Fundus photo. 45-degree field of view. 2048x1536px — 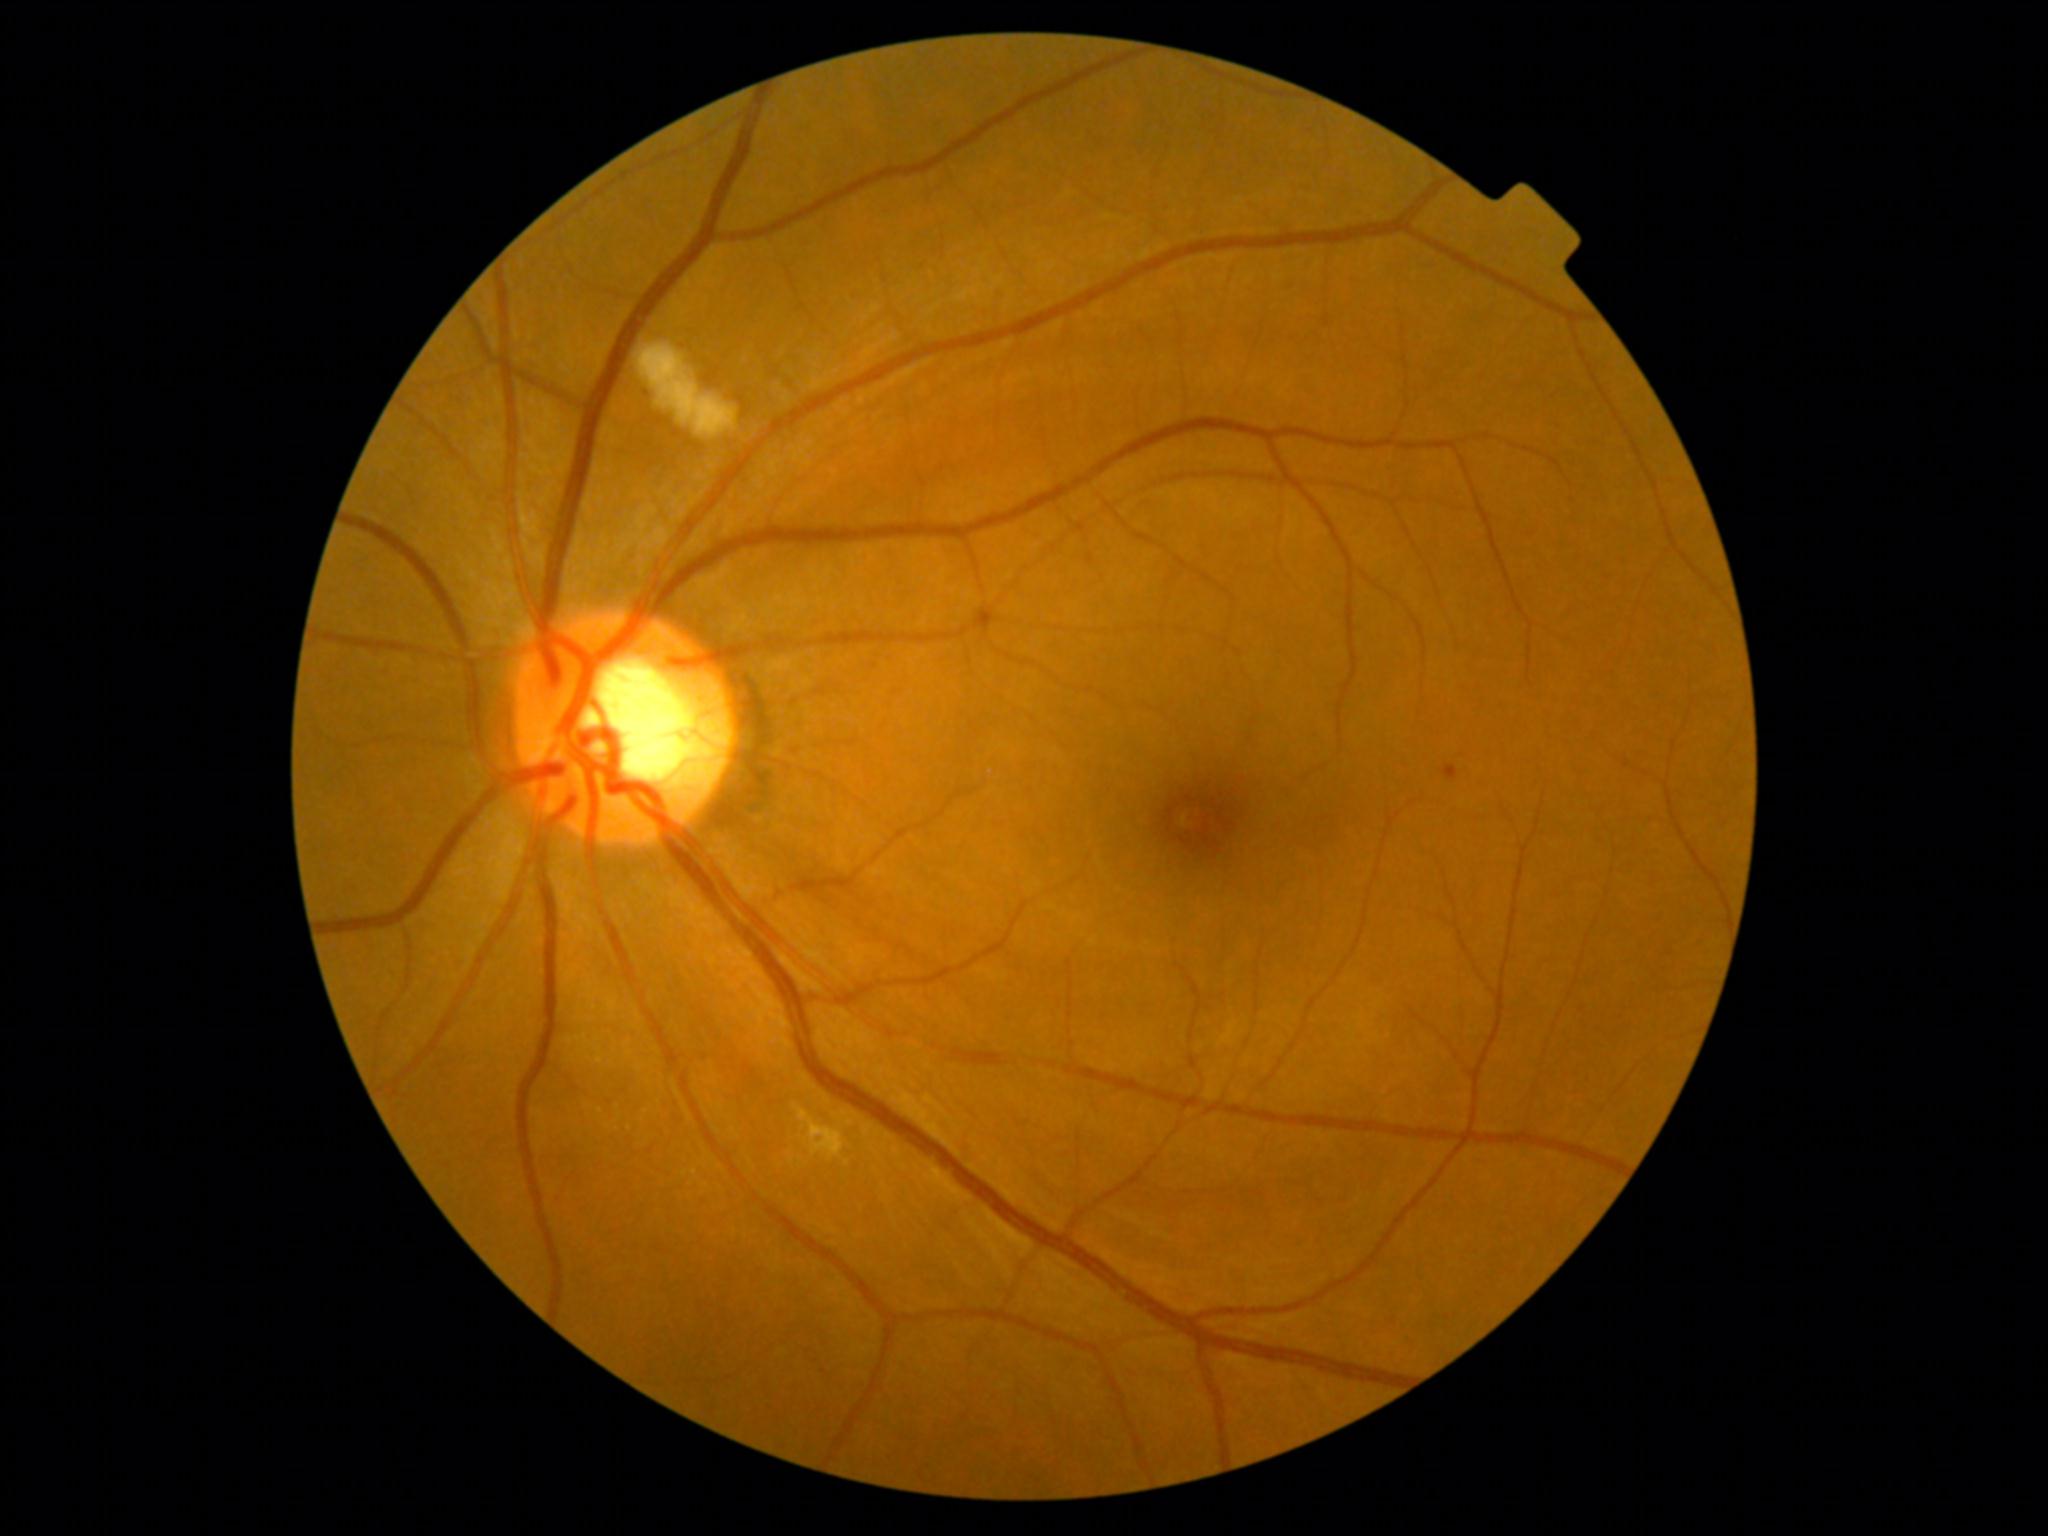 dr_grade: 2
dr_grade_name: moderate NPDR
lesions:
  ex:
    - (x1=793, y1=1106, x2=845, y2=1162)
  se:
    - (x1=640, y1=346, x2=739, y2=439)
  he: []
  ma:
    - (x1=642, y1=390, x2=654, y2=400)
    - (x1=1443, y1=766, x2=1459, y2=780)